2352x1568px, retinal fundus photograph:
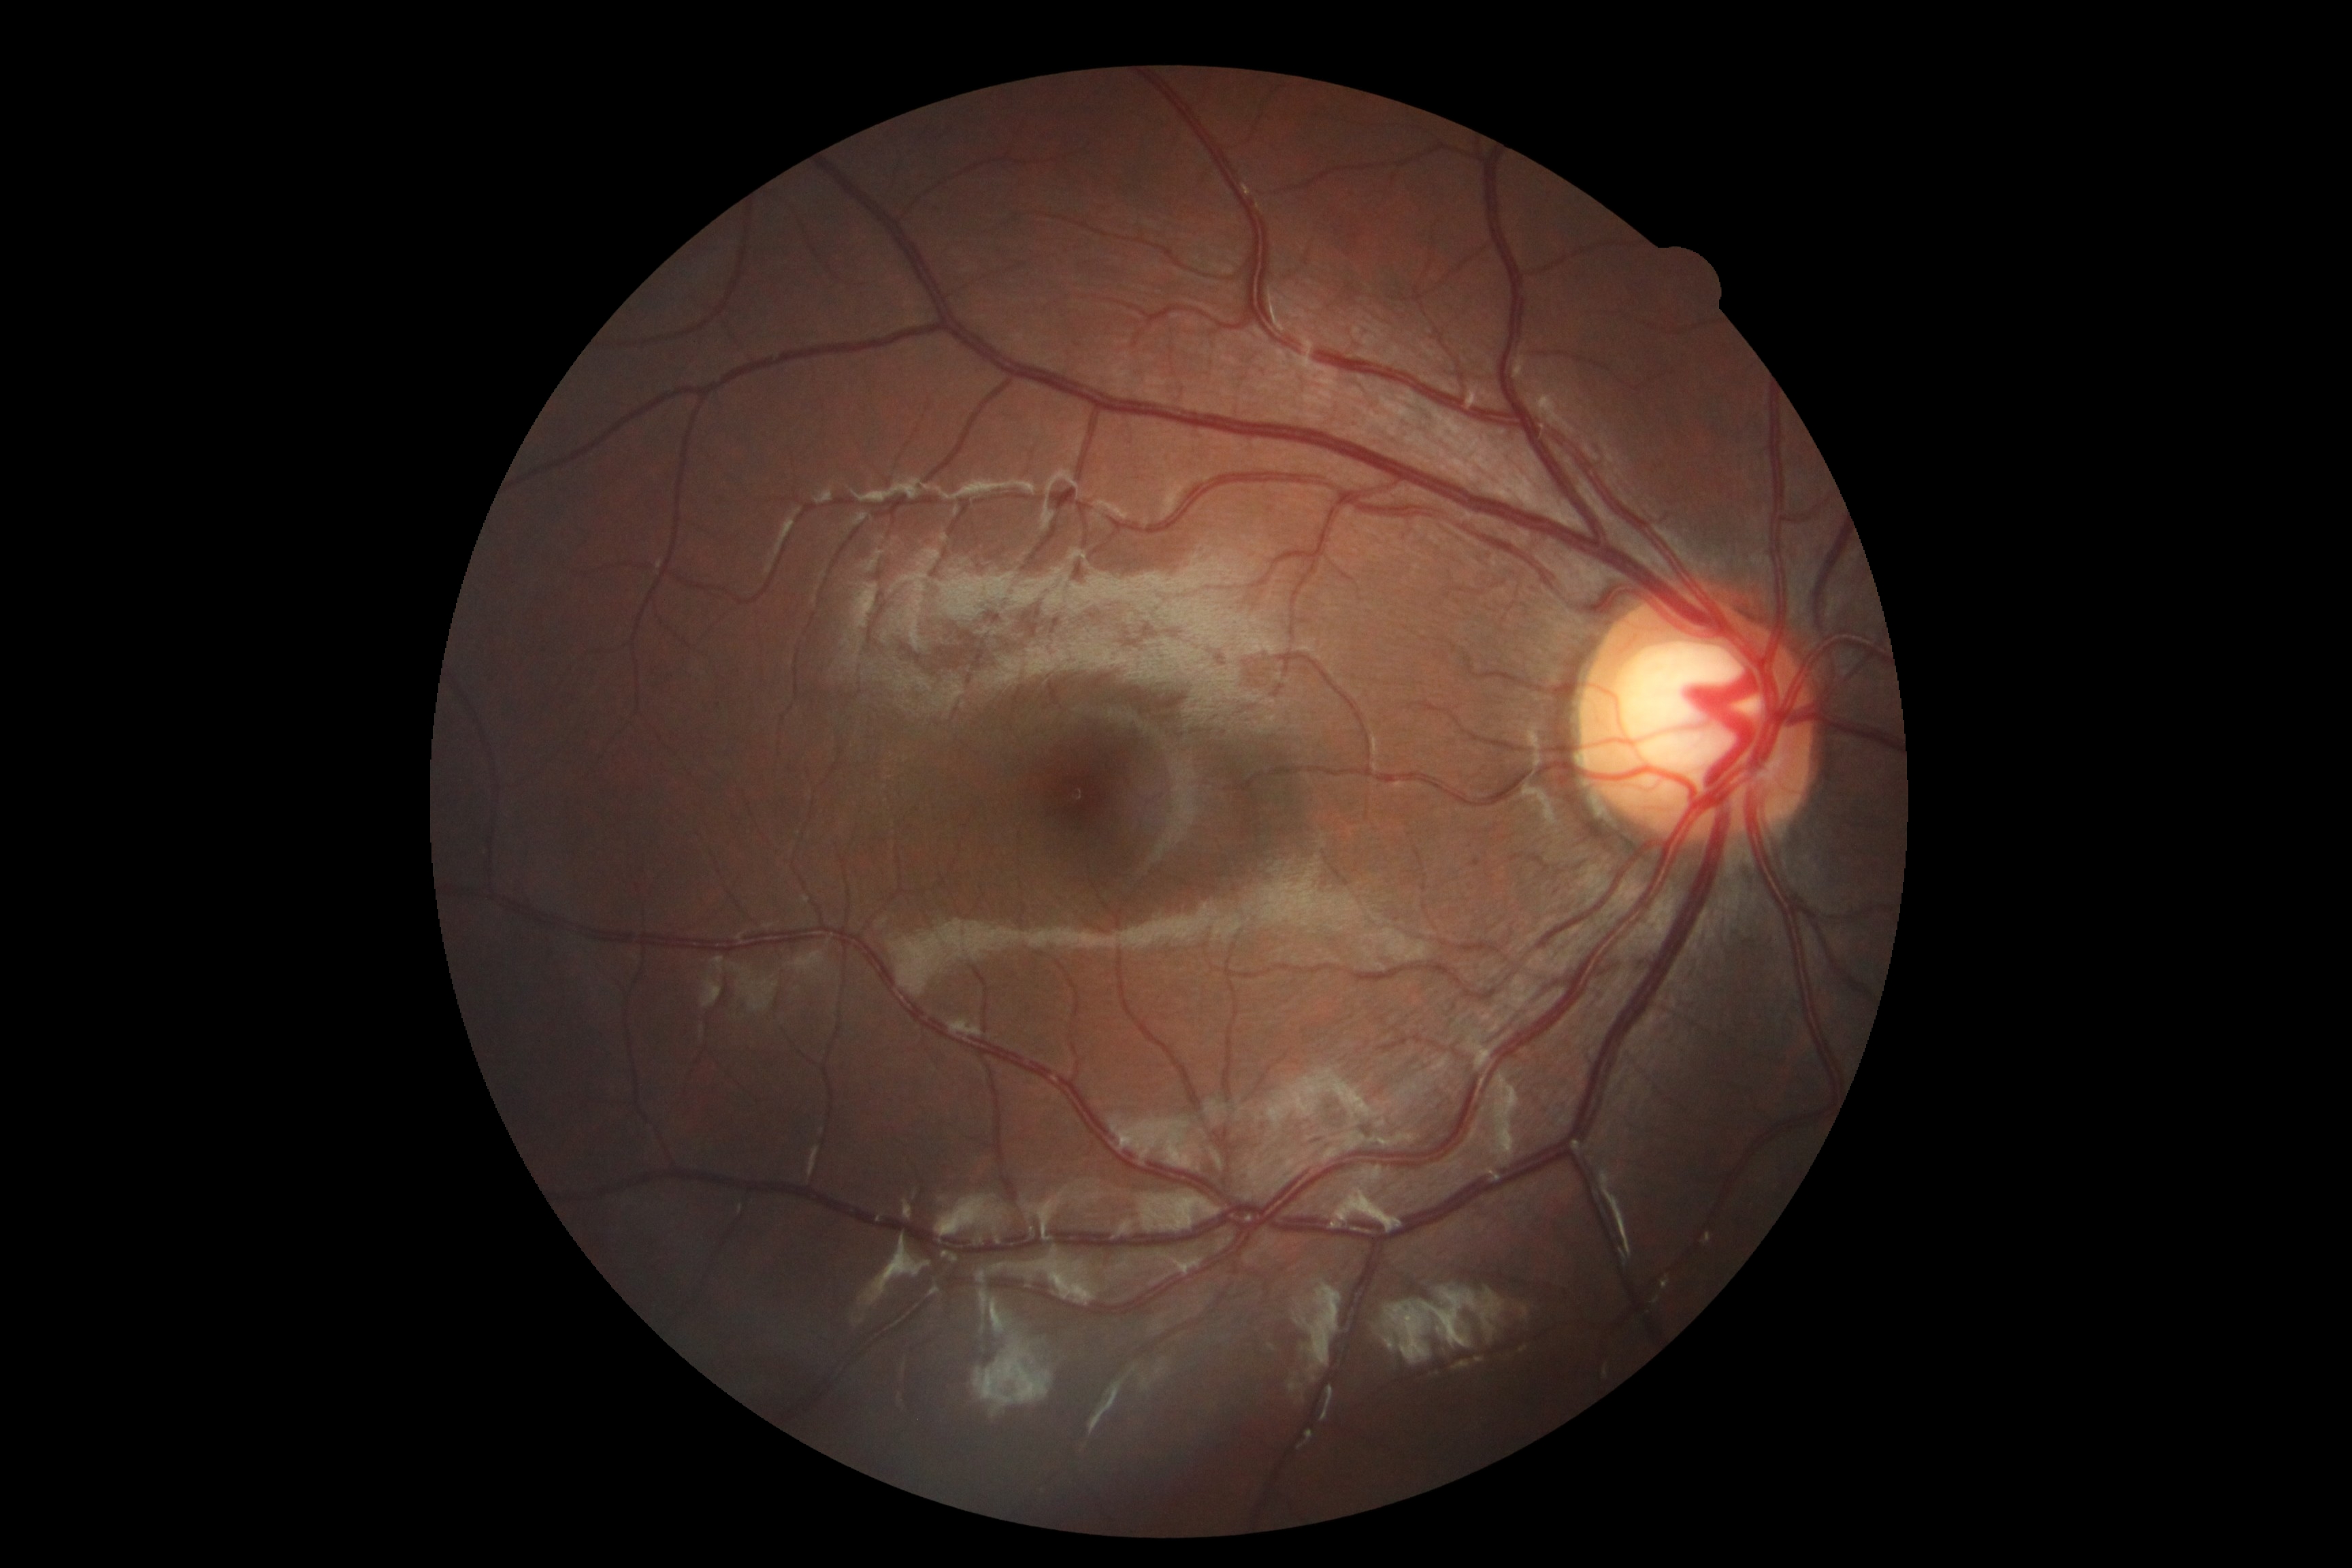 DR impression@negative for DR; retinopathy@no apparent retinopathy (grade 0).